45° FOV:
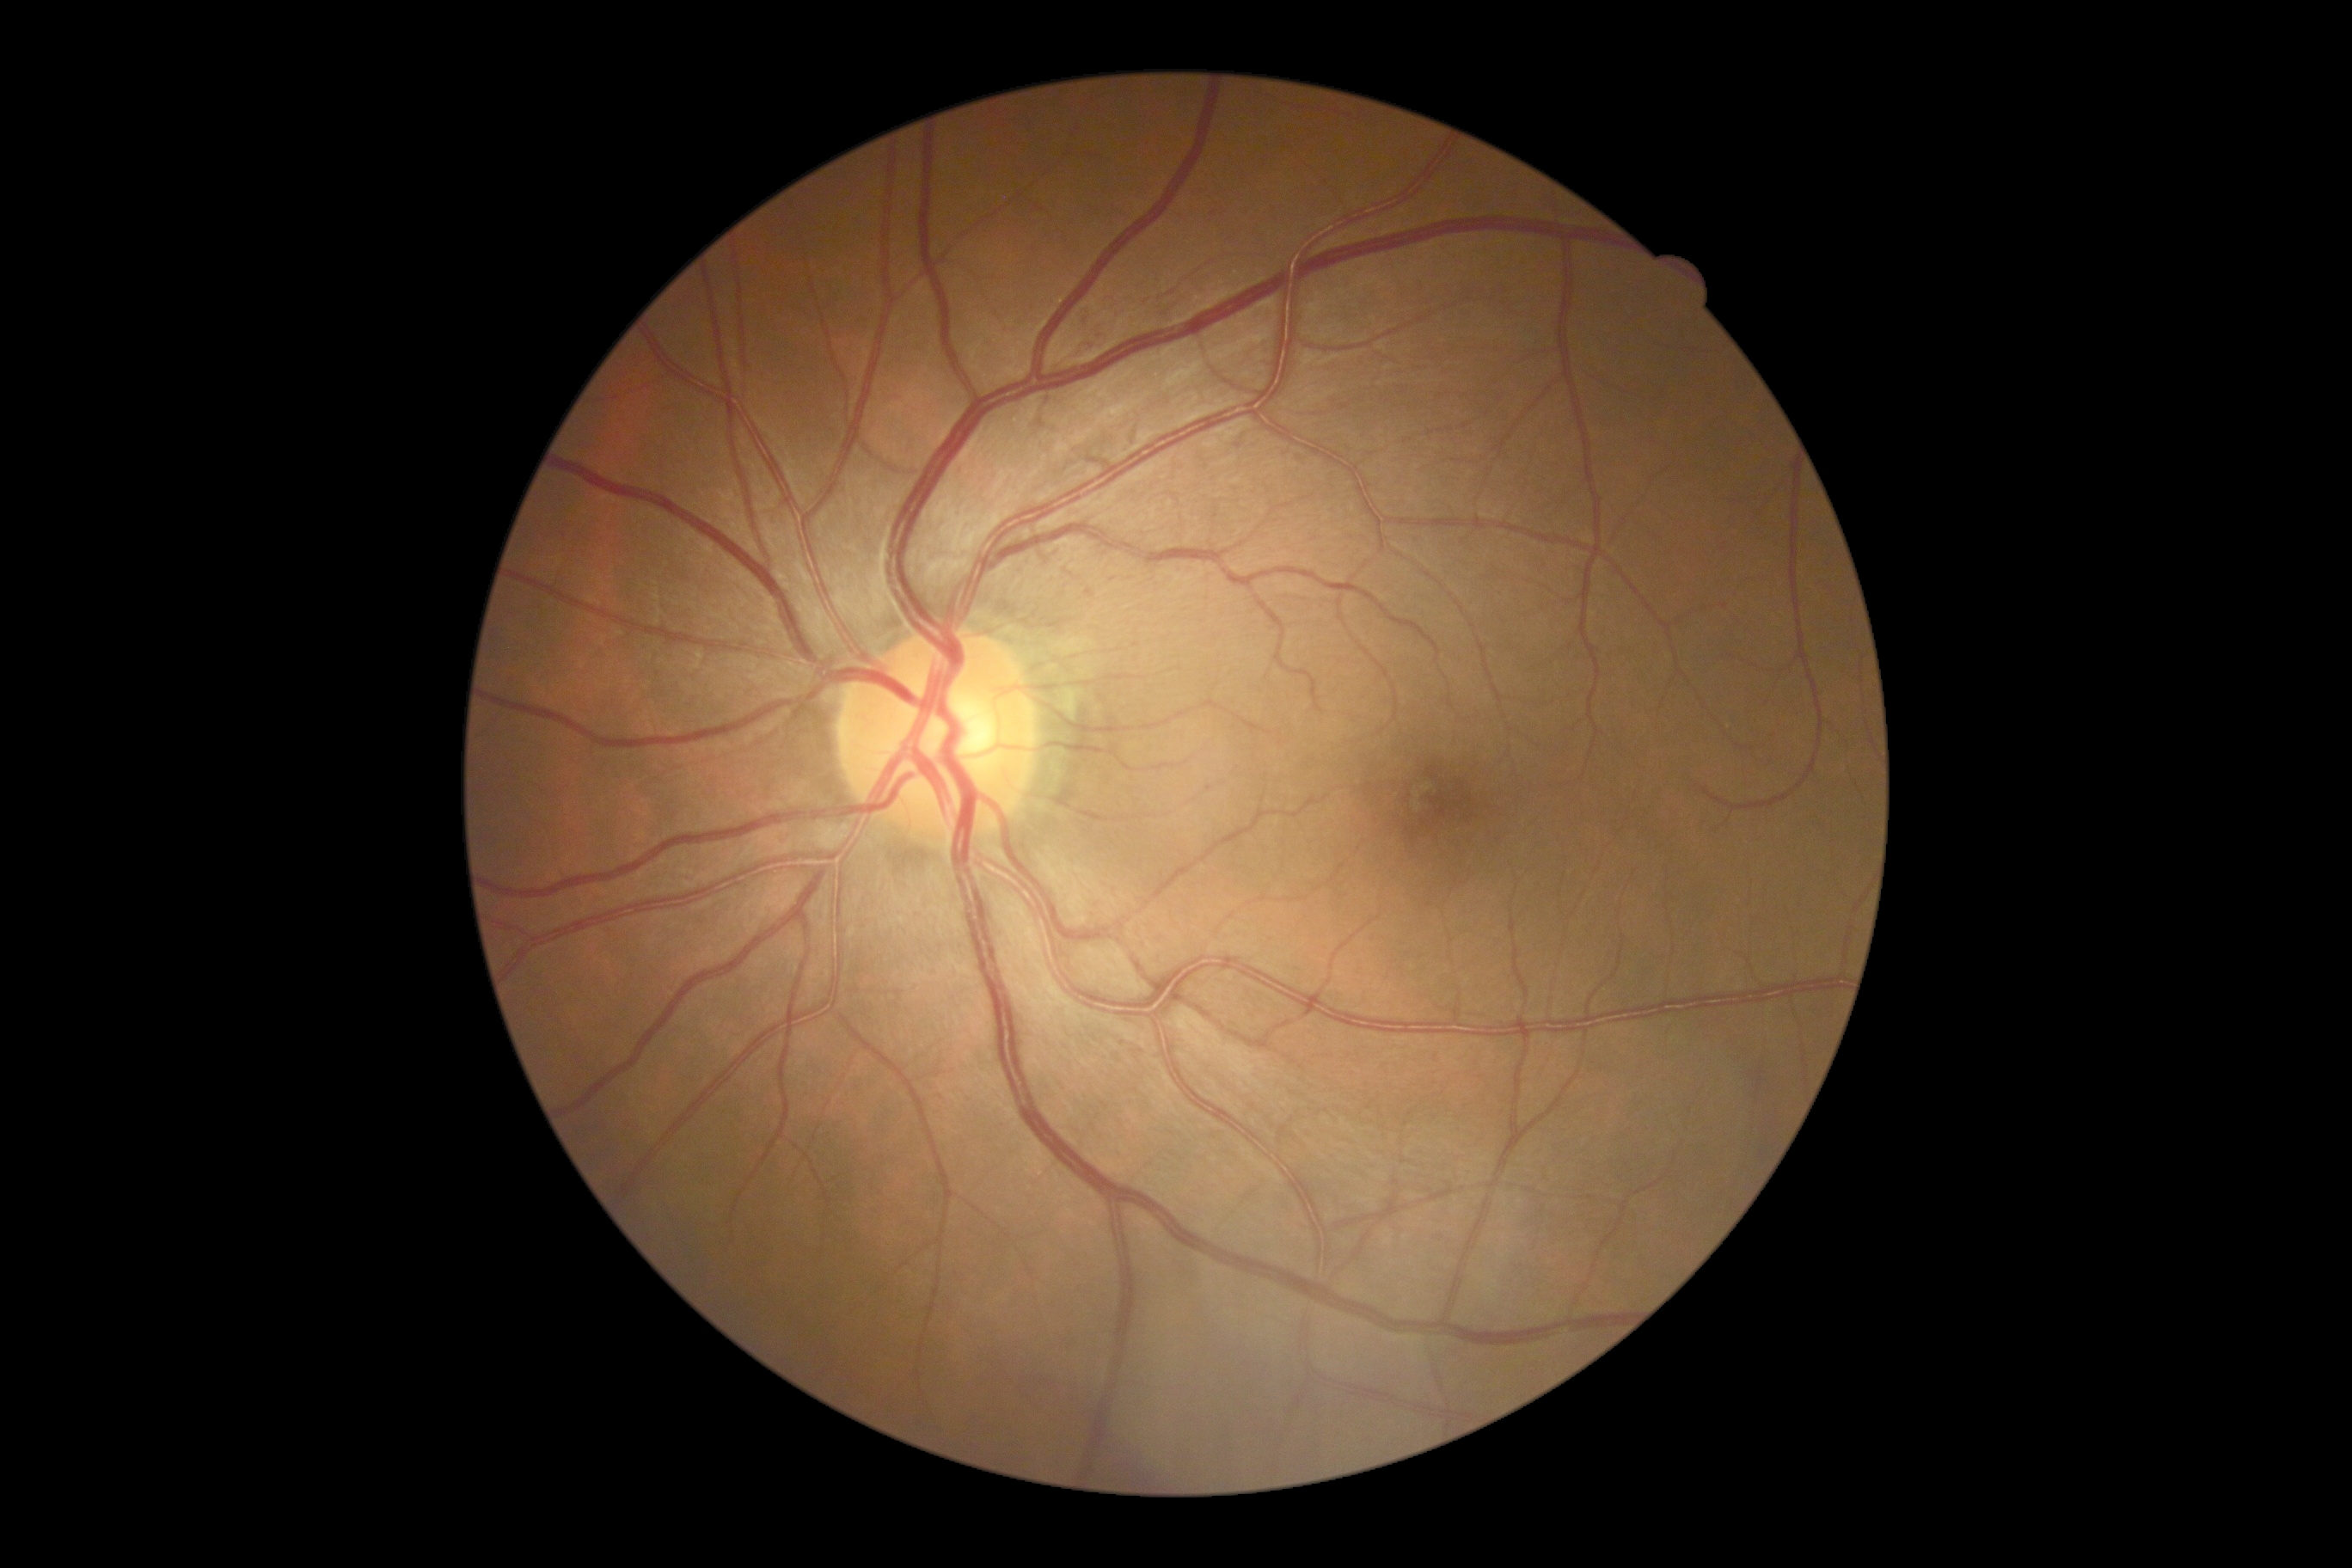

retinopathy grade: no apparent retinopathy (0).